Wide-field fundus image from infant ROP screening — 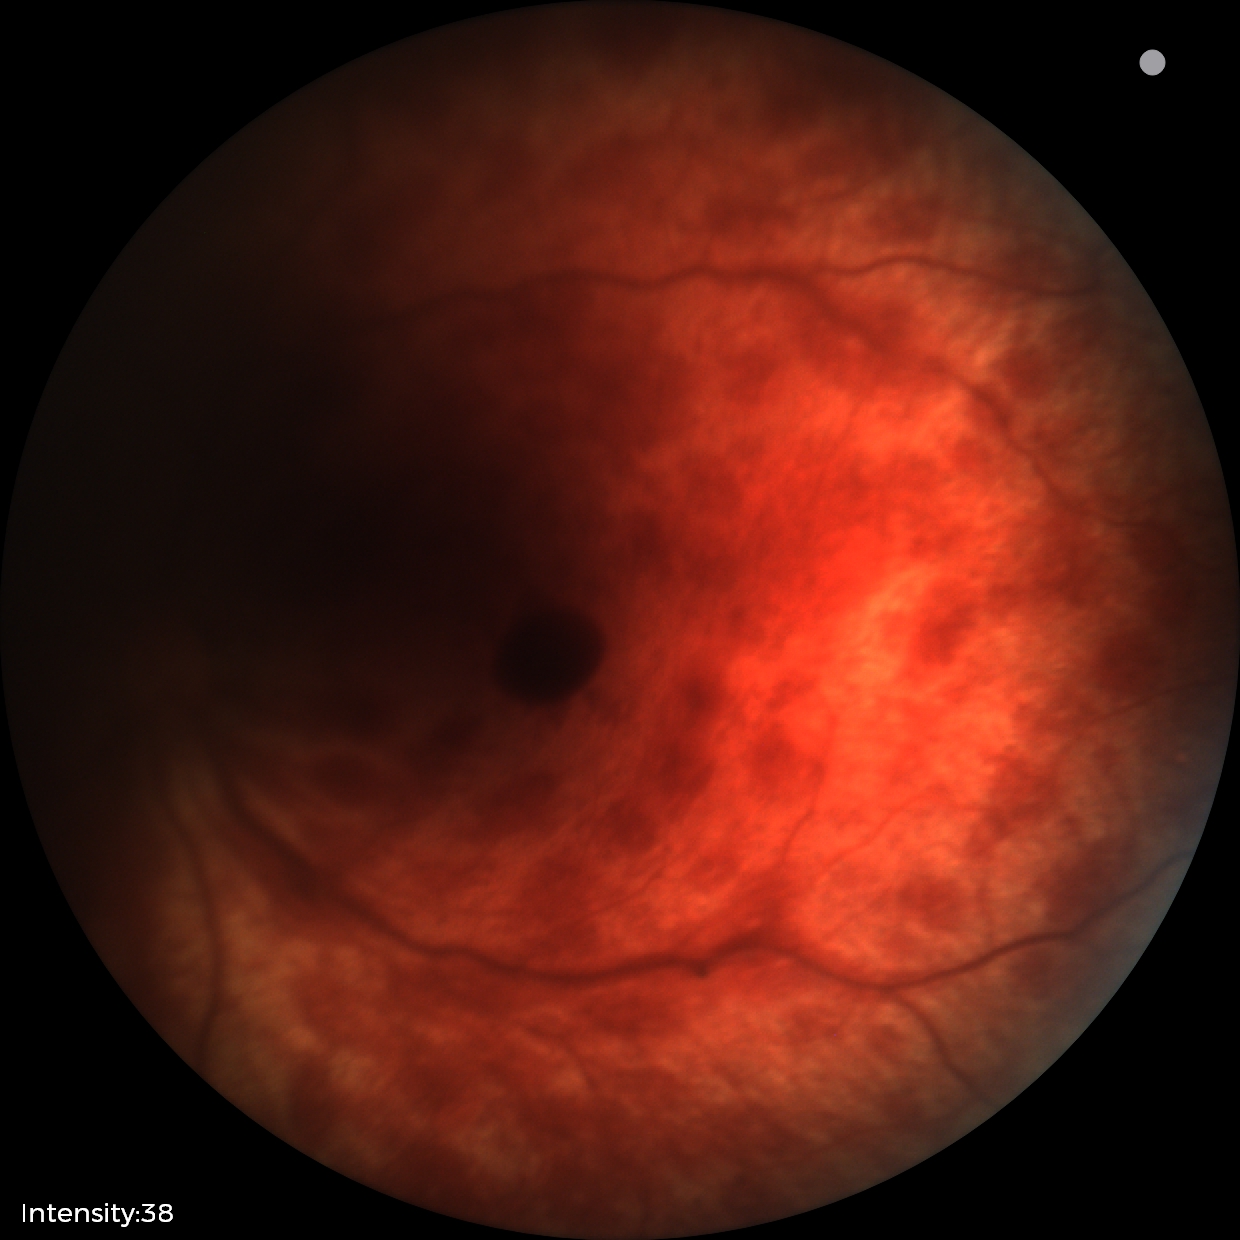
Finding = retinal hemorrhages.